Image size 848x848. Nonmydriatic fundus photograph. Modified Davis classification: 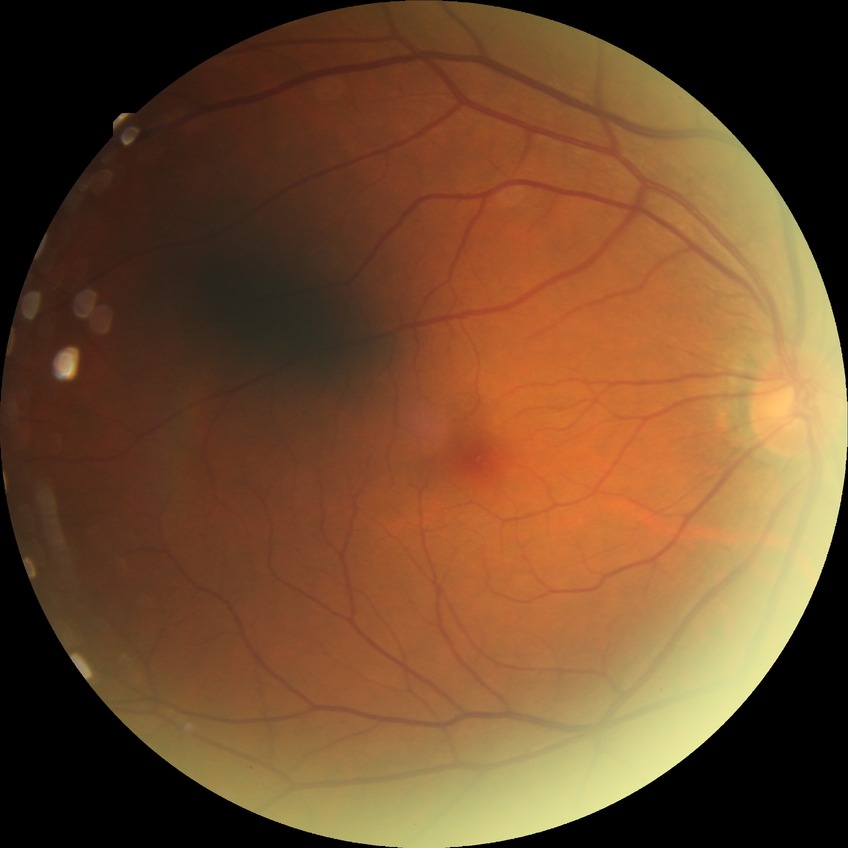

Assessment:
• diabetic retinopathy (DR): NDR (no diabetic retinopathy)